Fundus photo
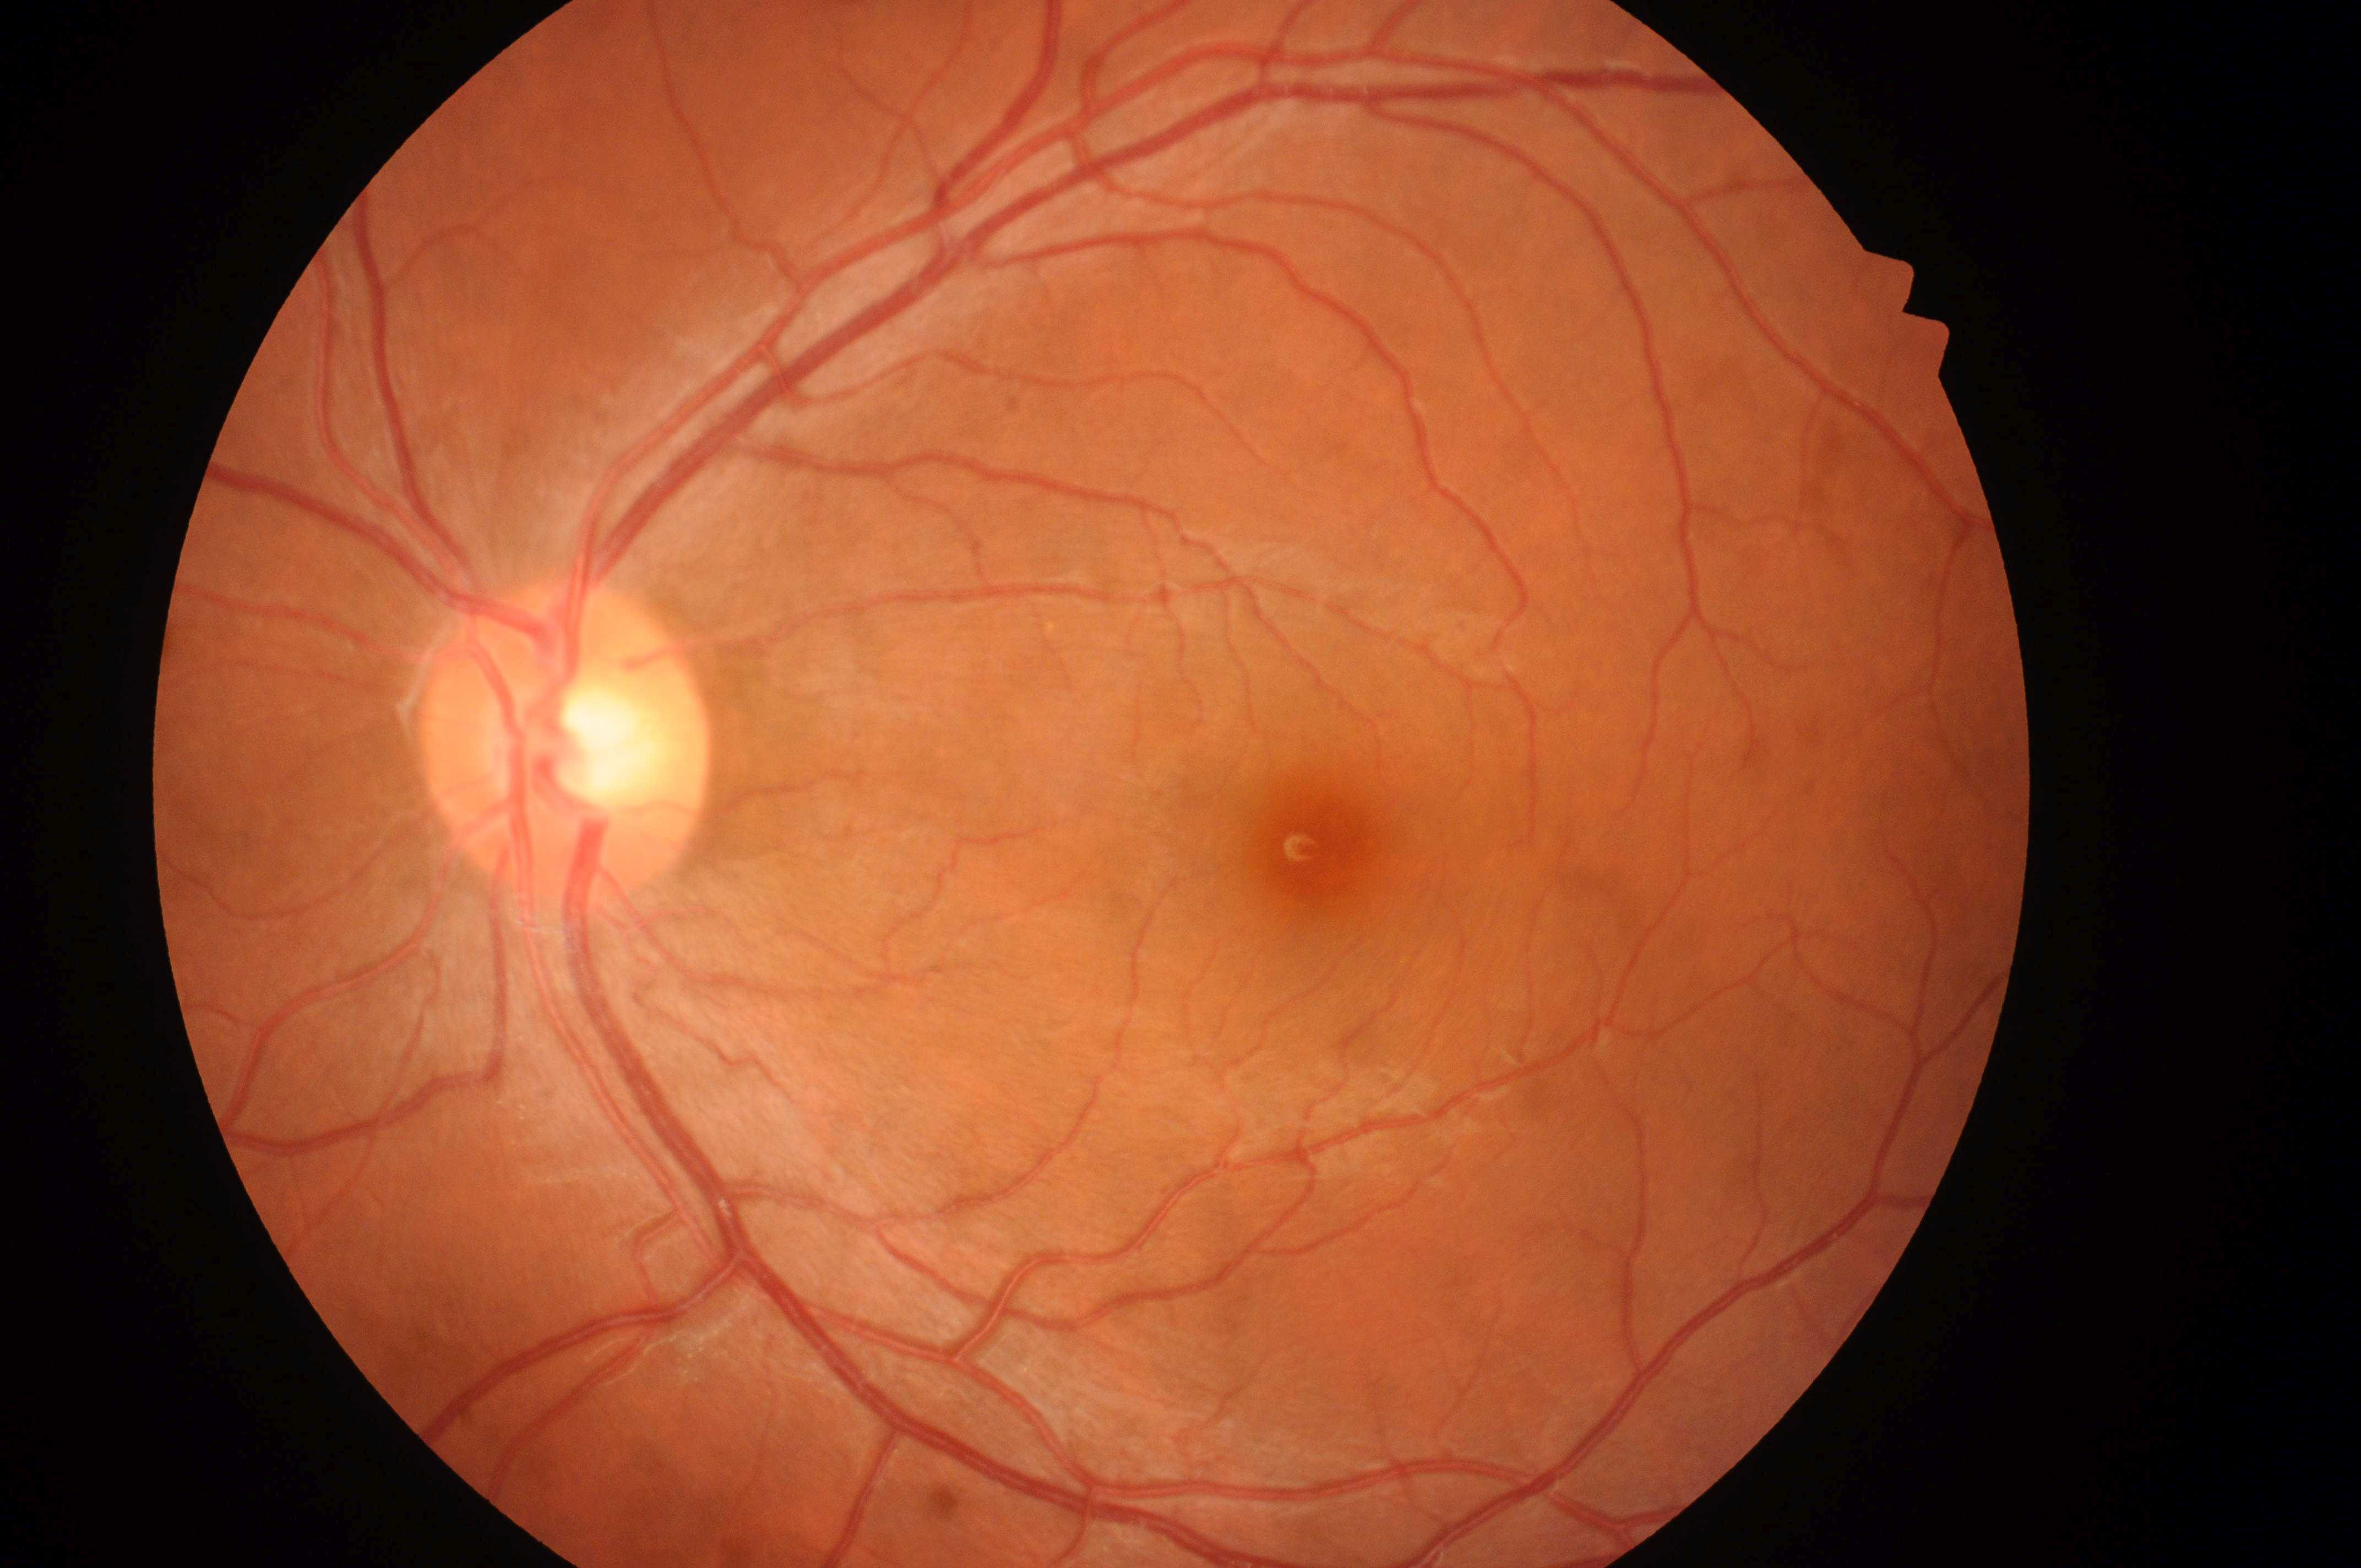 fovea center@(1320, 850)
macular edema risk@grade 0 (no risk)
No signs of diabetic retinopathy or diabetic macular edema
optic disc center@(563, 759)
oculus sinister
retinopathy@no apparent retinopathy (grade 0)